FOV: 45 degrees:
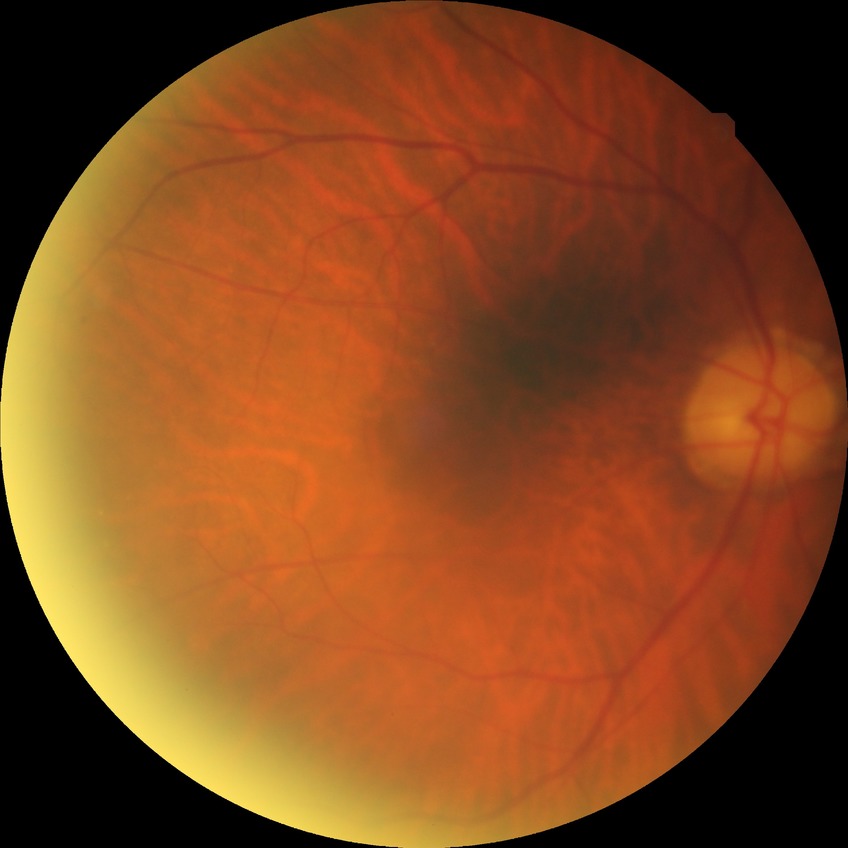
{
  "davis_grade": "no diabetic retinopathy"
}